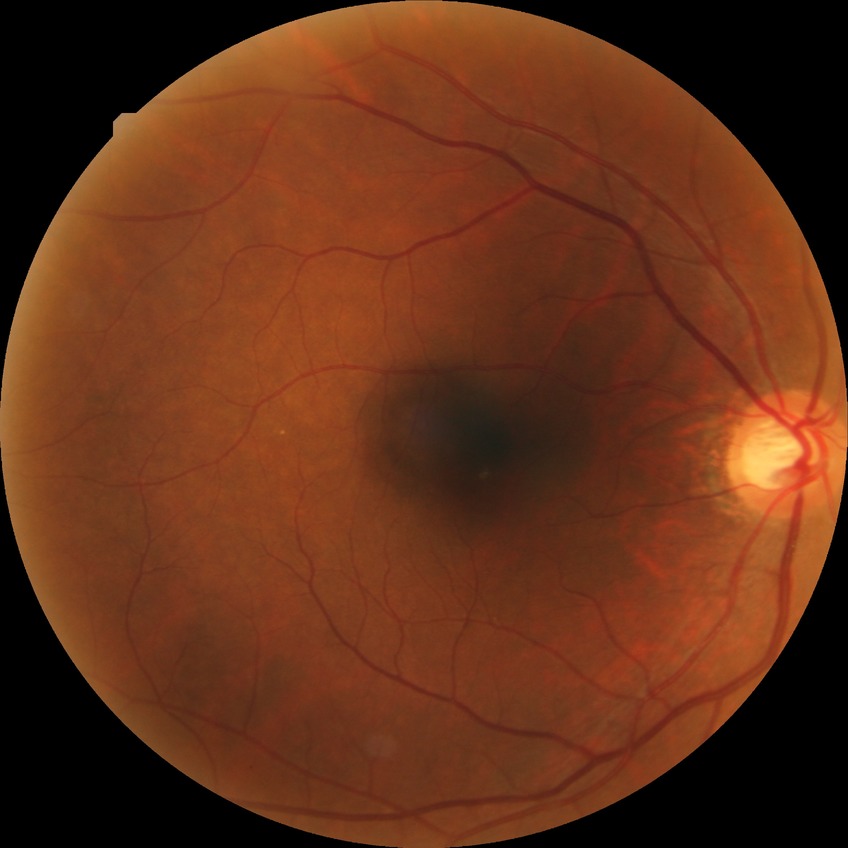 Diabetic retinopathy (DR) is NDR (no diabetic retinopathy).